Fundus photo — 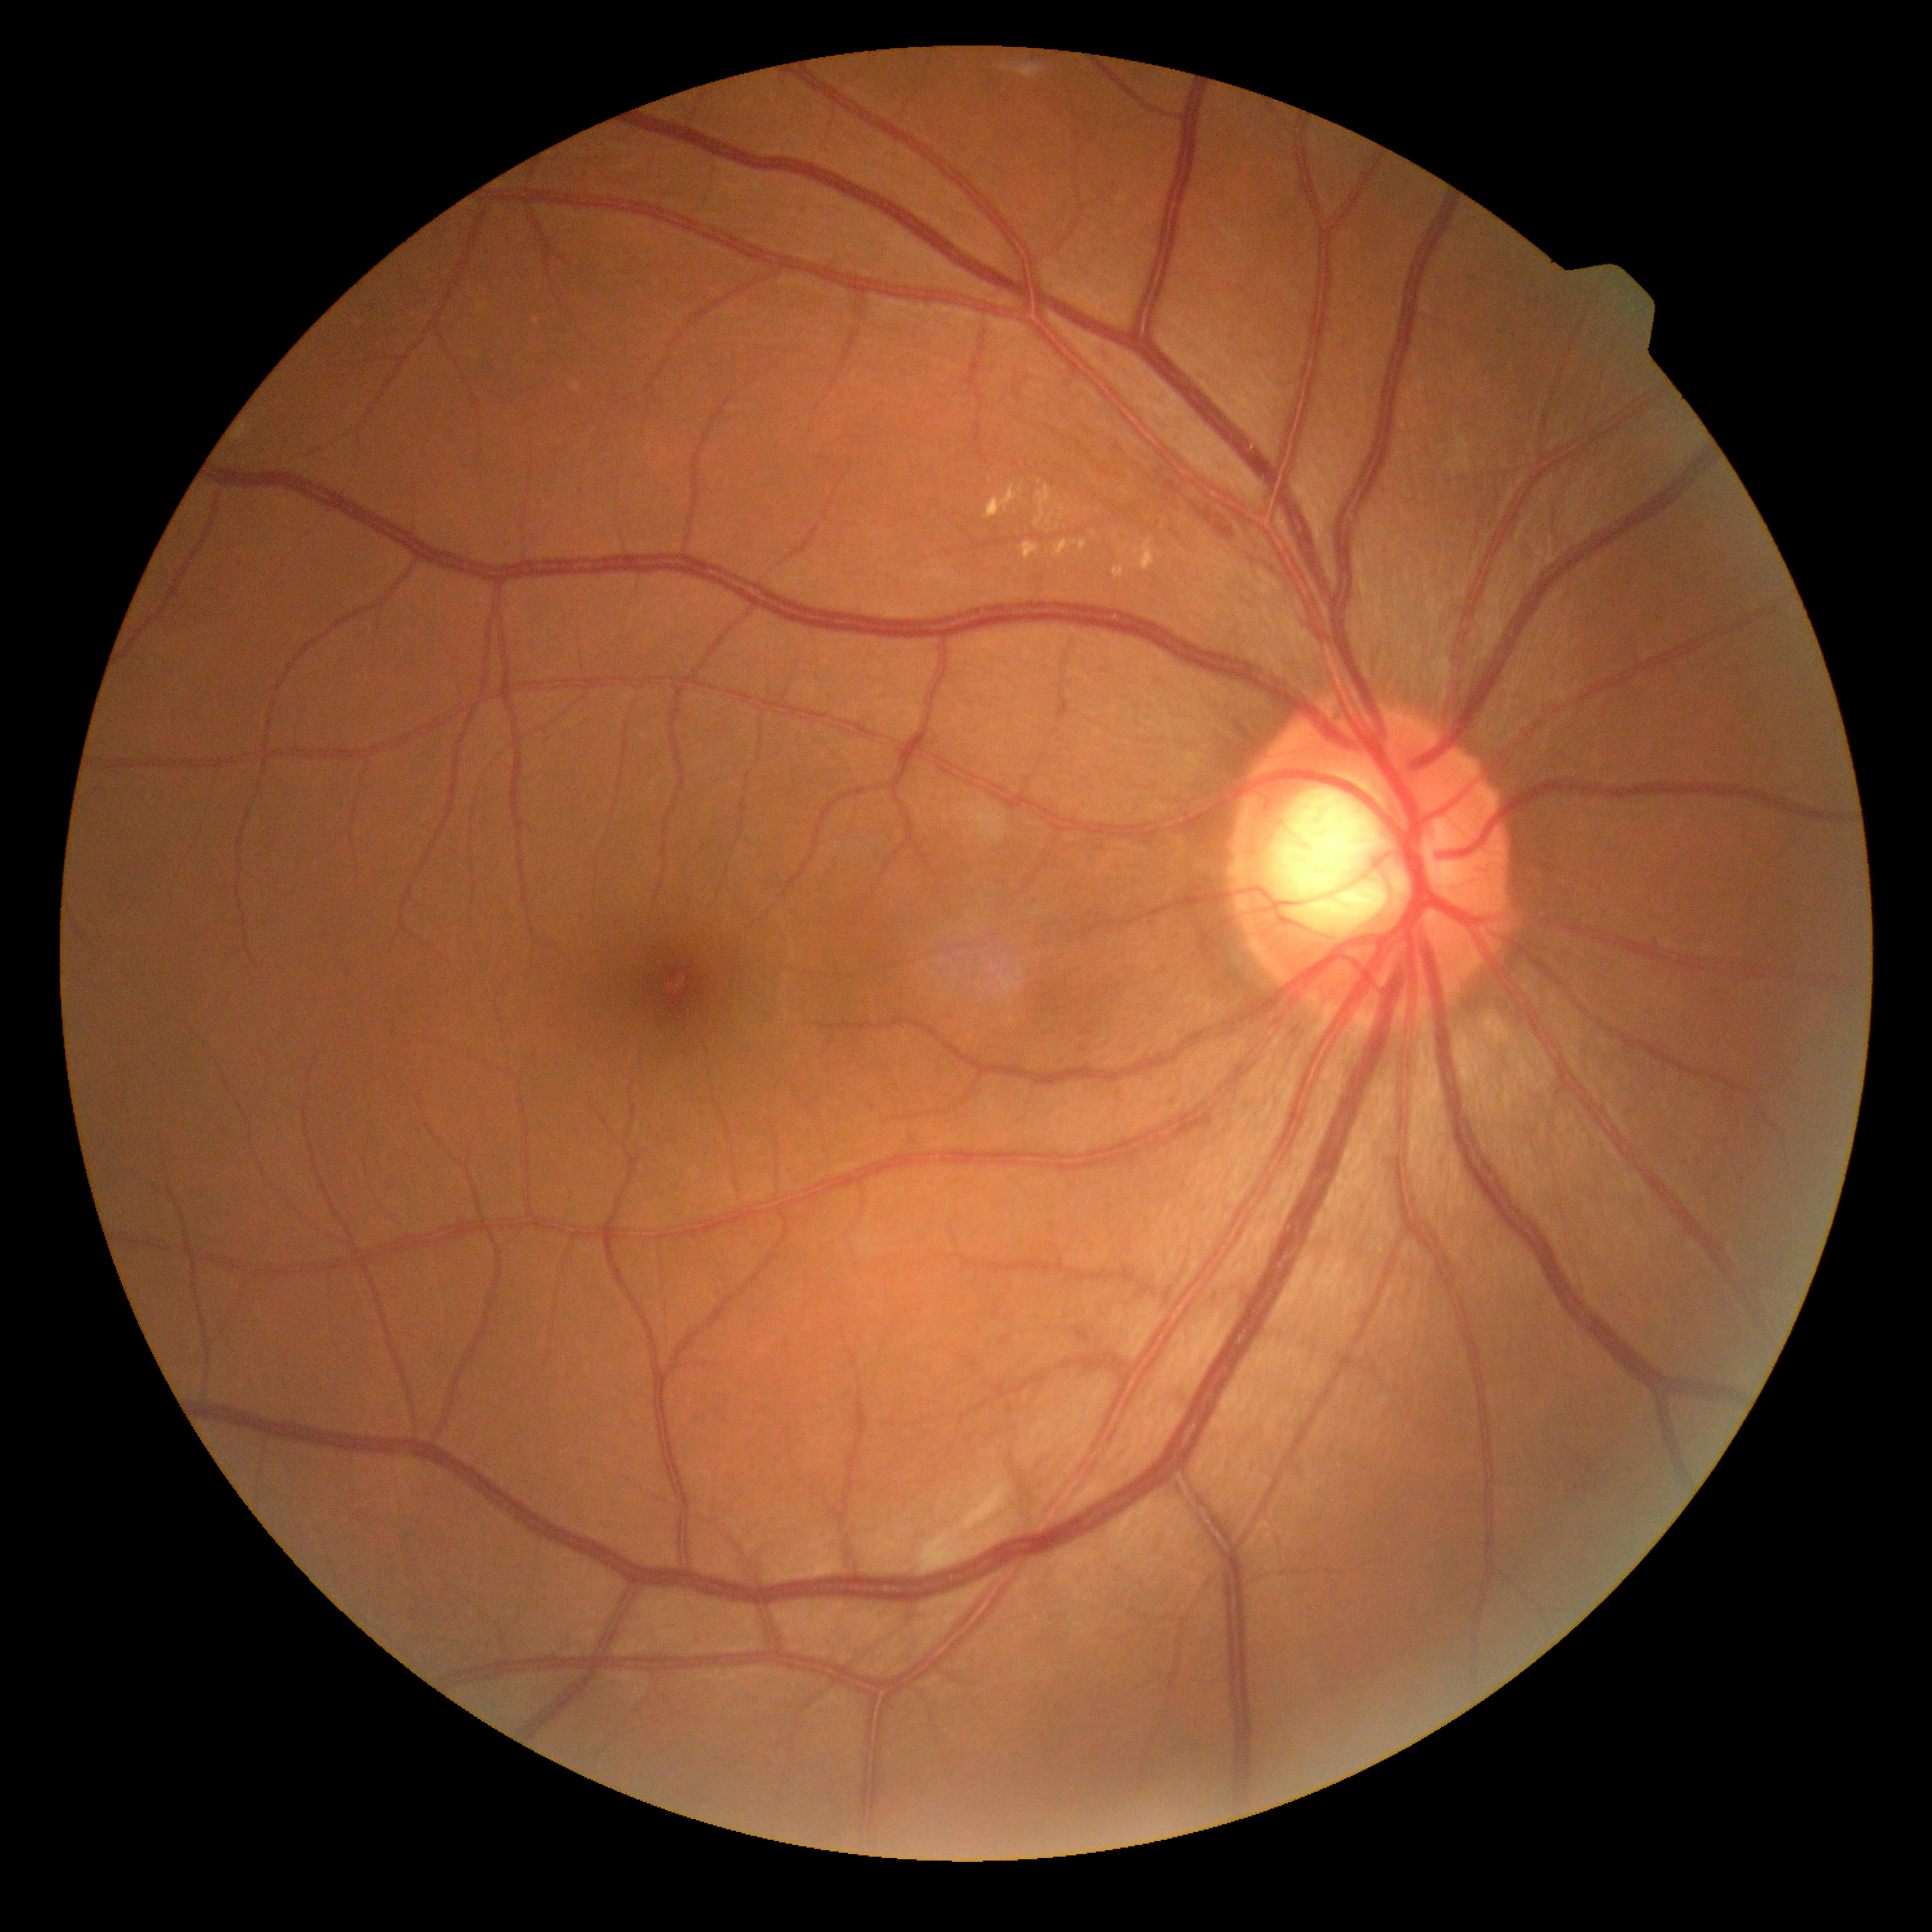

DR is grade 2 (moderate NPDR).